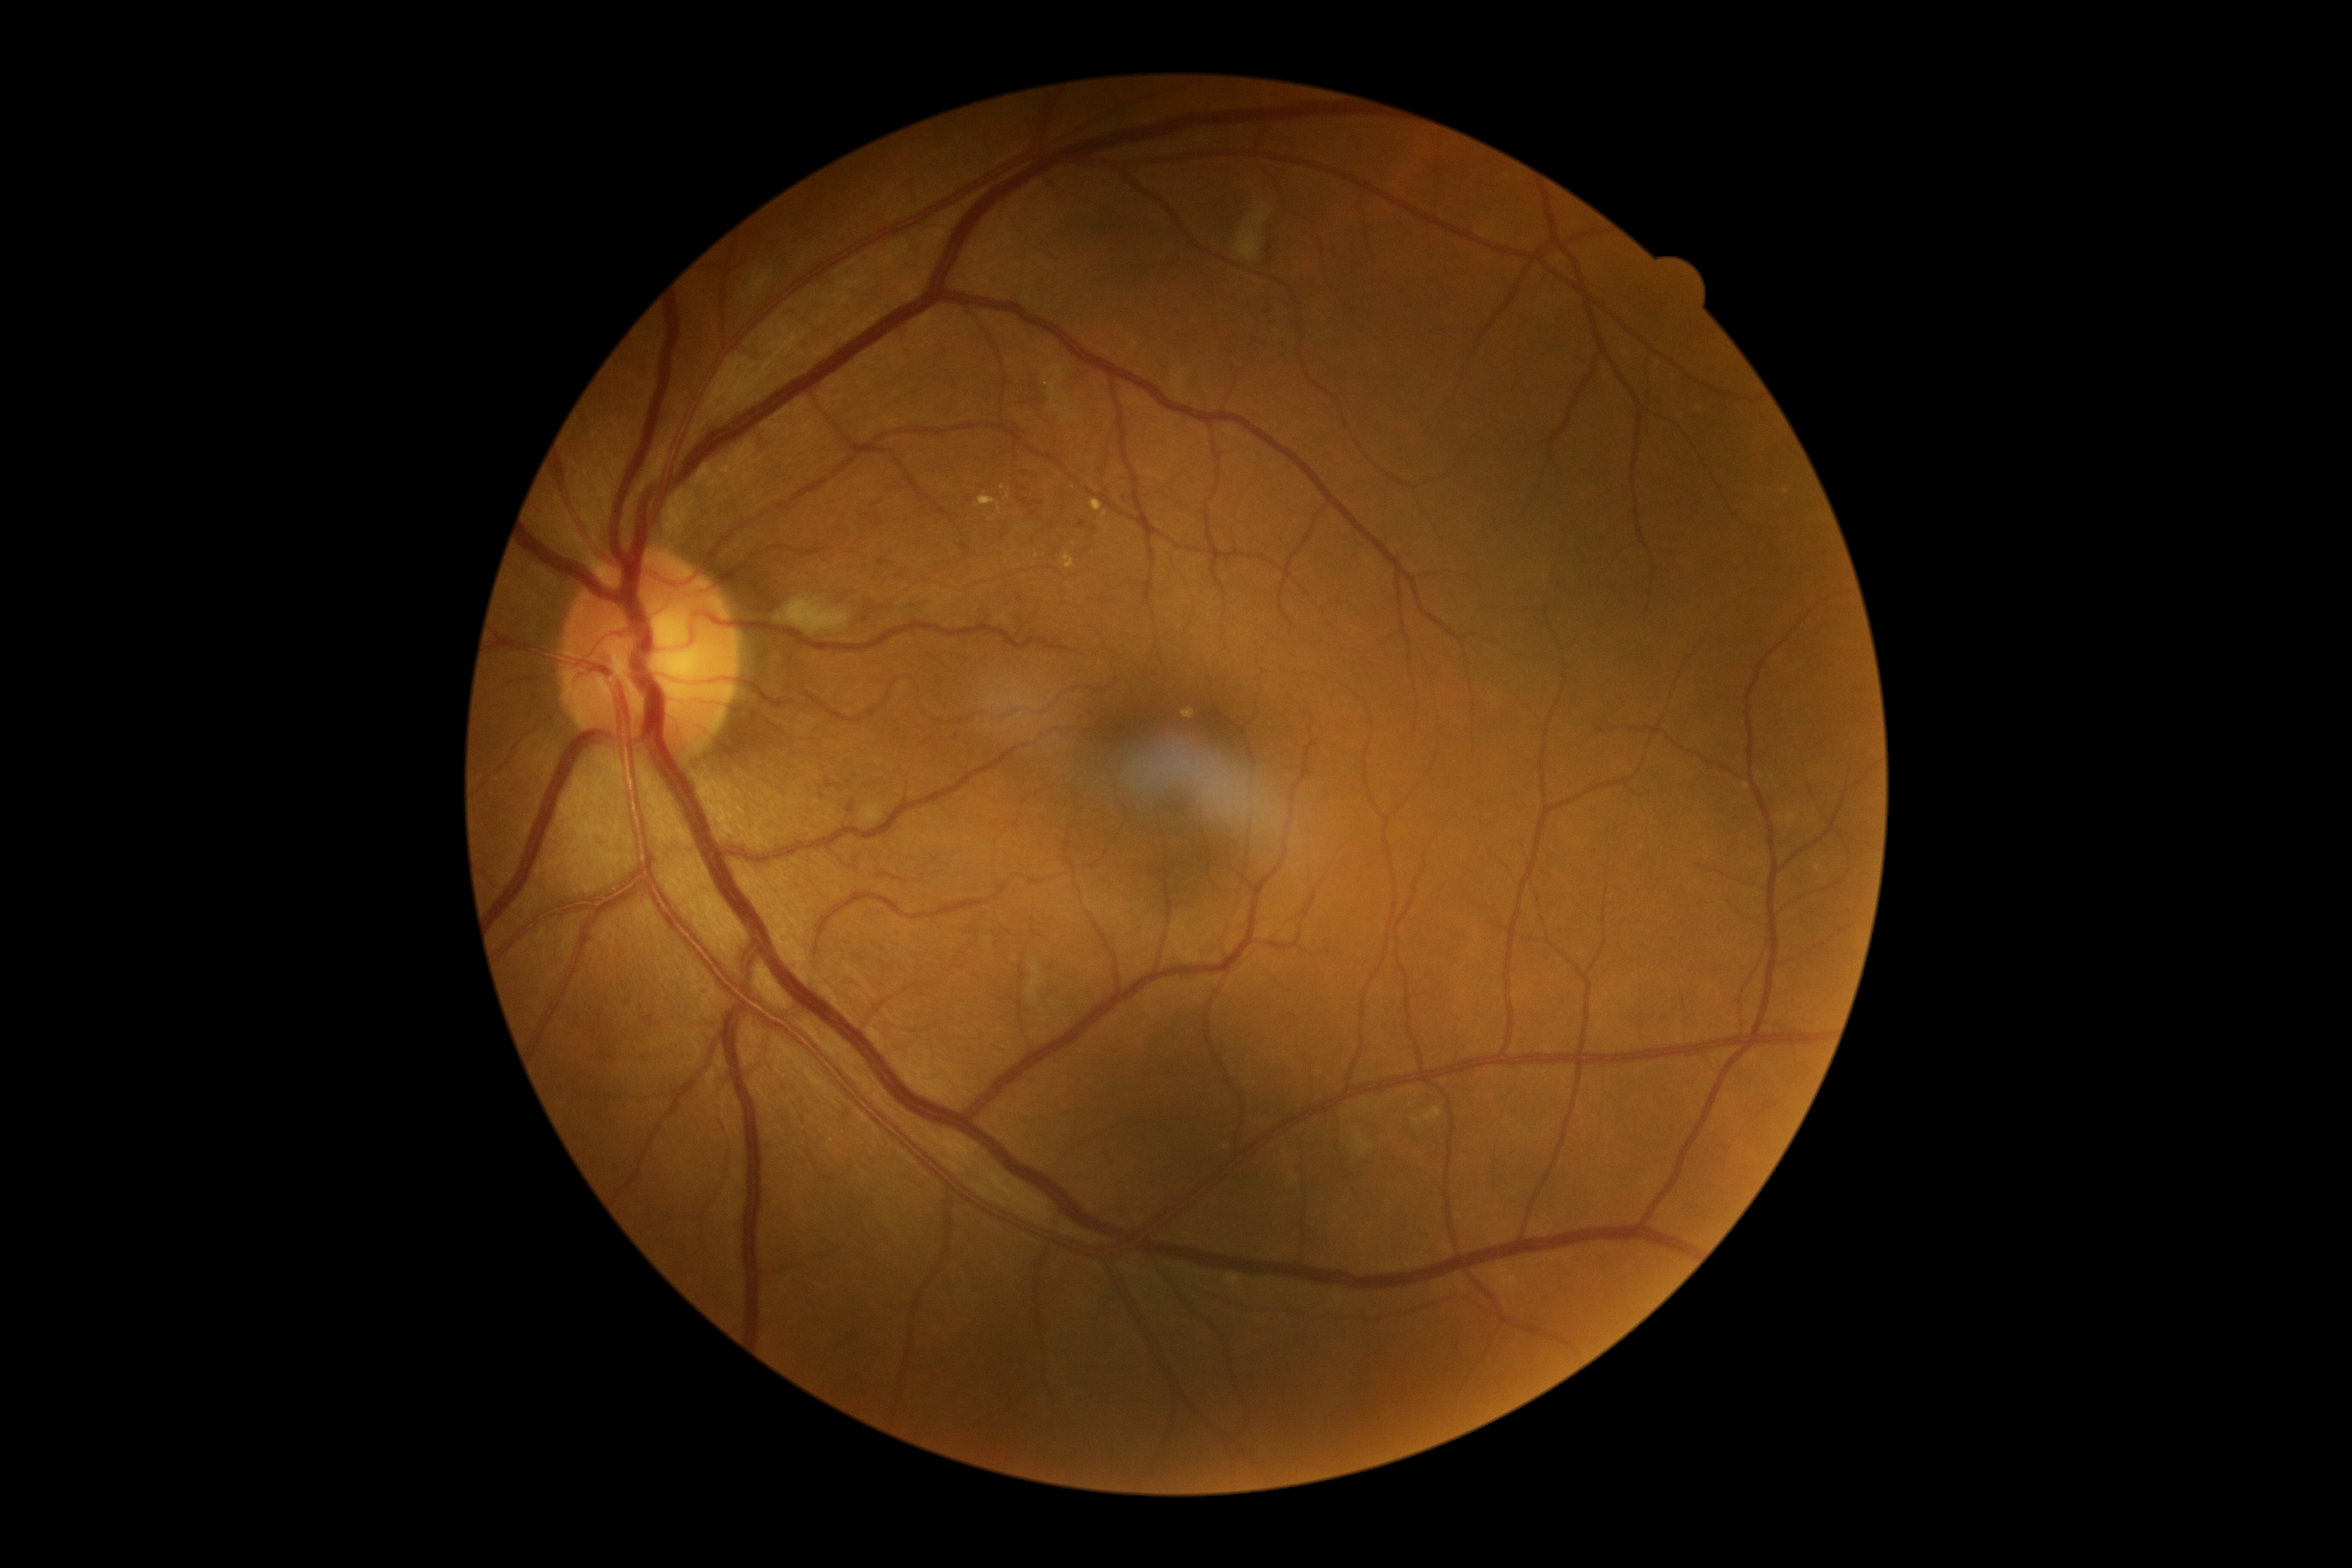

<lesions partial="true">
  <dr_grade>2</dr_grade>
  <ma partial="true">region(644, 1017, 652, 1027), region(862, 618, 871, 623), region(1020, 498, 1043, 510), region(1079, 520, 1087, 529), region(1022, 469, 1036, 481)</ma>
  <ma_small_centers>x=848 y=781, x=1020 y=600, x=821 y=797, x=1101 y=470, x=1785 y=783, x=970 y=501, x=1034 y=514</ma_small_centers>
  <he />
  <se>region(1029, 964, 1043, 1000), region(1235, 204, 1271, 262), region(861, 802, 883, 823), region(1354, 1132, 1375, 1156), region(778, 592, 852, 637)</se>
  <ex partial="true">region(976, 496, 1001, 511), region(1063, 556, 1075, 570), region(1182, 709, 1196, 718), region(1093, 499, 1103, 511)</ex>
  <ex_small_centers>x=1037 y=558, x=1104 y=514, x=992 y=520, x=1007 y=497, x=1002 y=488</ex_small_centers>
</lesions>